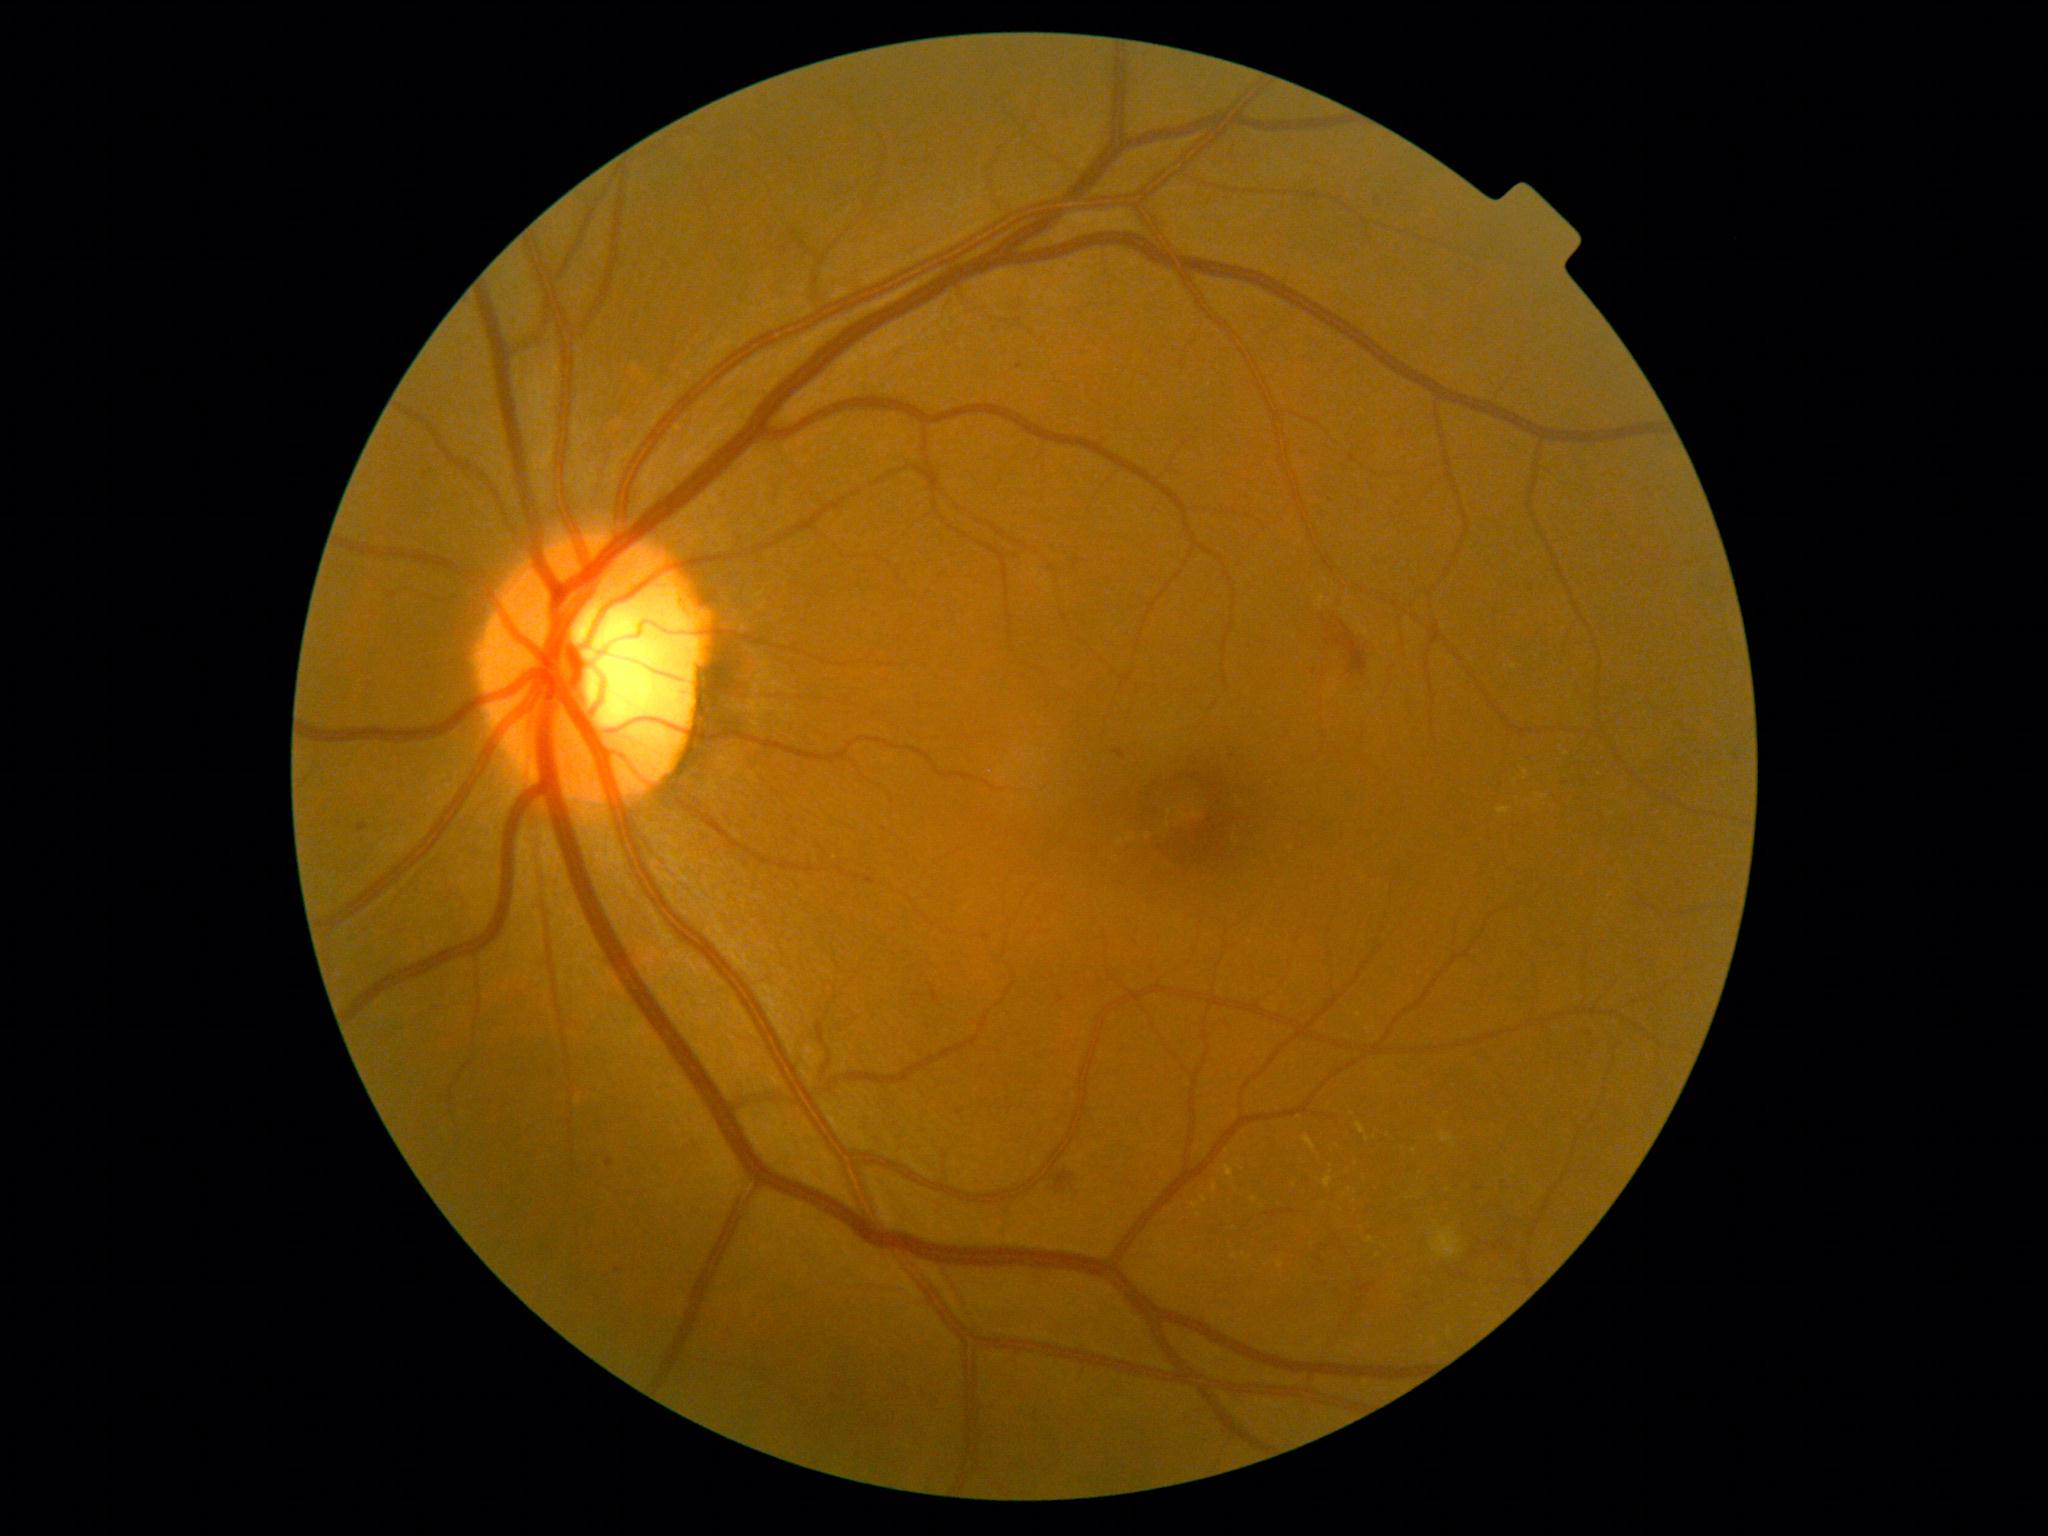

Diabetic retinopathy (DR): grade 2
Selected lesions:
hard exudates (EXs) (more not shown): x1=1192, y1=1204, x2=1200, y2=1209; x1=1497, y1=808, x2=1510, y2=815; x1=1278, y1=1262, x2=1284, y2=1270; x1=1302, y1=1136, x2=1317, y2=1153; x1=1538, y1=796, x2=1546, y2=800; x1=1357, y1=1123, x2=1367, y2=1135; x1=1328, y1=1143, x2=1337, y2=1155
Additional small EXs near <pt>1331,1173</pt>; <pt>1370,1240</pt>; <pt>1415,1151</pt>; <pt>1295,1186</pt>; <pt>1367,1140</pt>; <pt>1199,1216</pt>
soft exudates (SEs): x1=1432, y1=1229, x2=1463, y2=1258
hemorrhages (HEs): x1=1320, y1=620, x2=1368, y2=677; x1=1053, y1=1172, x2=1076, y2=1195
microaneurysms (MAs) (more not shown): x1=1320, y1=1280, x2=1330, y2=1287; x1=1113, y1=750, x2=1126, y2=760; x1=357, y1=823, x2=368, y2=833; x1=607, y1=1159, x2=614, y2=1168
Additional small MAs near <pt>618,1271</pt>; <pt>1020,366</pt>; <pt>1565,784</pt>; <pt>1322,1261</pt>; <pt>1502,1183</pt>; <pt>1324,1251</pt>; <pt>1590,1035</pt>; <pt>1479,1189</pt>